Diabetic retinopathy graded by the modified Davis classification. Fundus photo
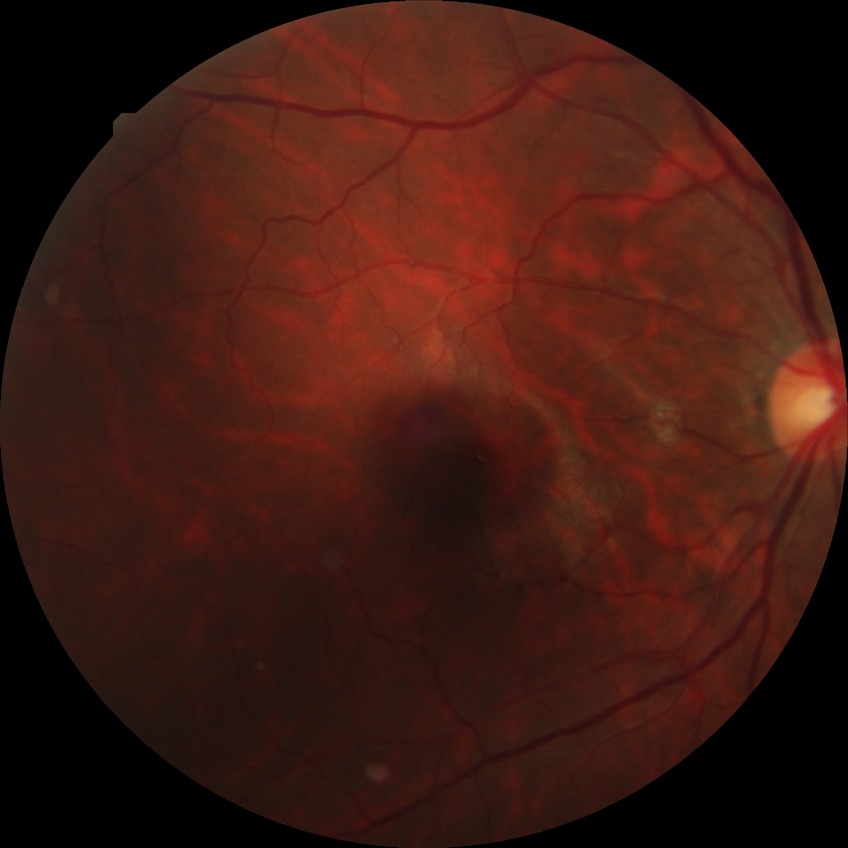

{"davis_grade": "no diabetic retinopathy"}